Infant wide-field fundus photograph. Captured with the Phoenix ICON (100° field of view):
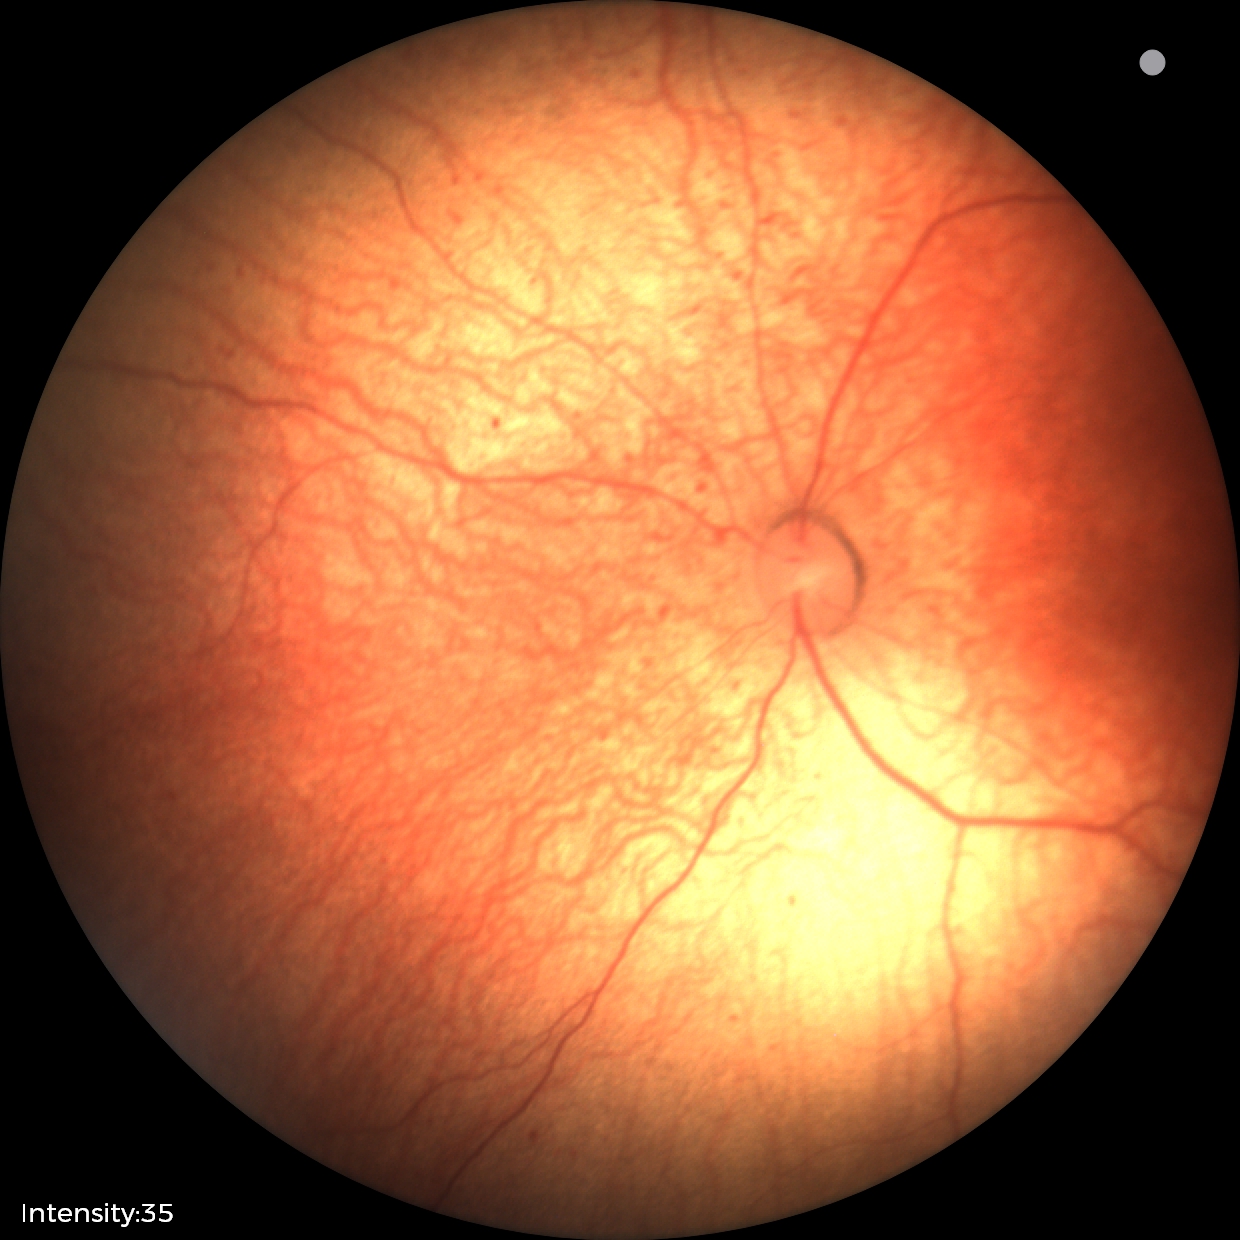 Screening series with status post ROP. No plus disease.